50-degree field of view.
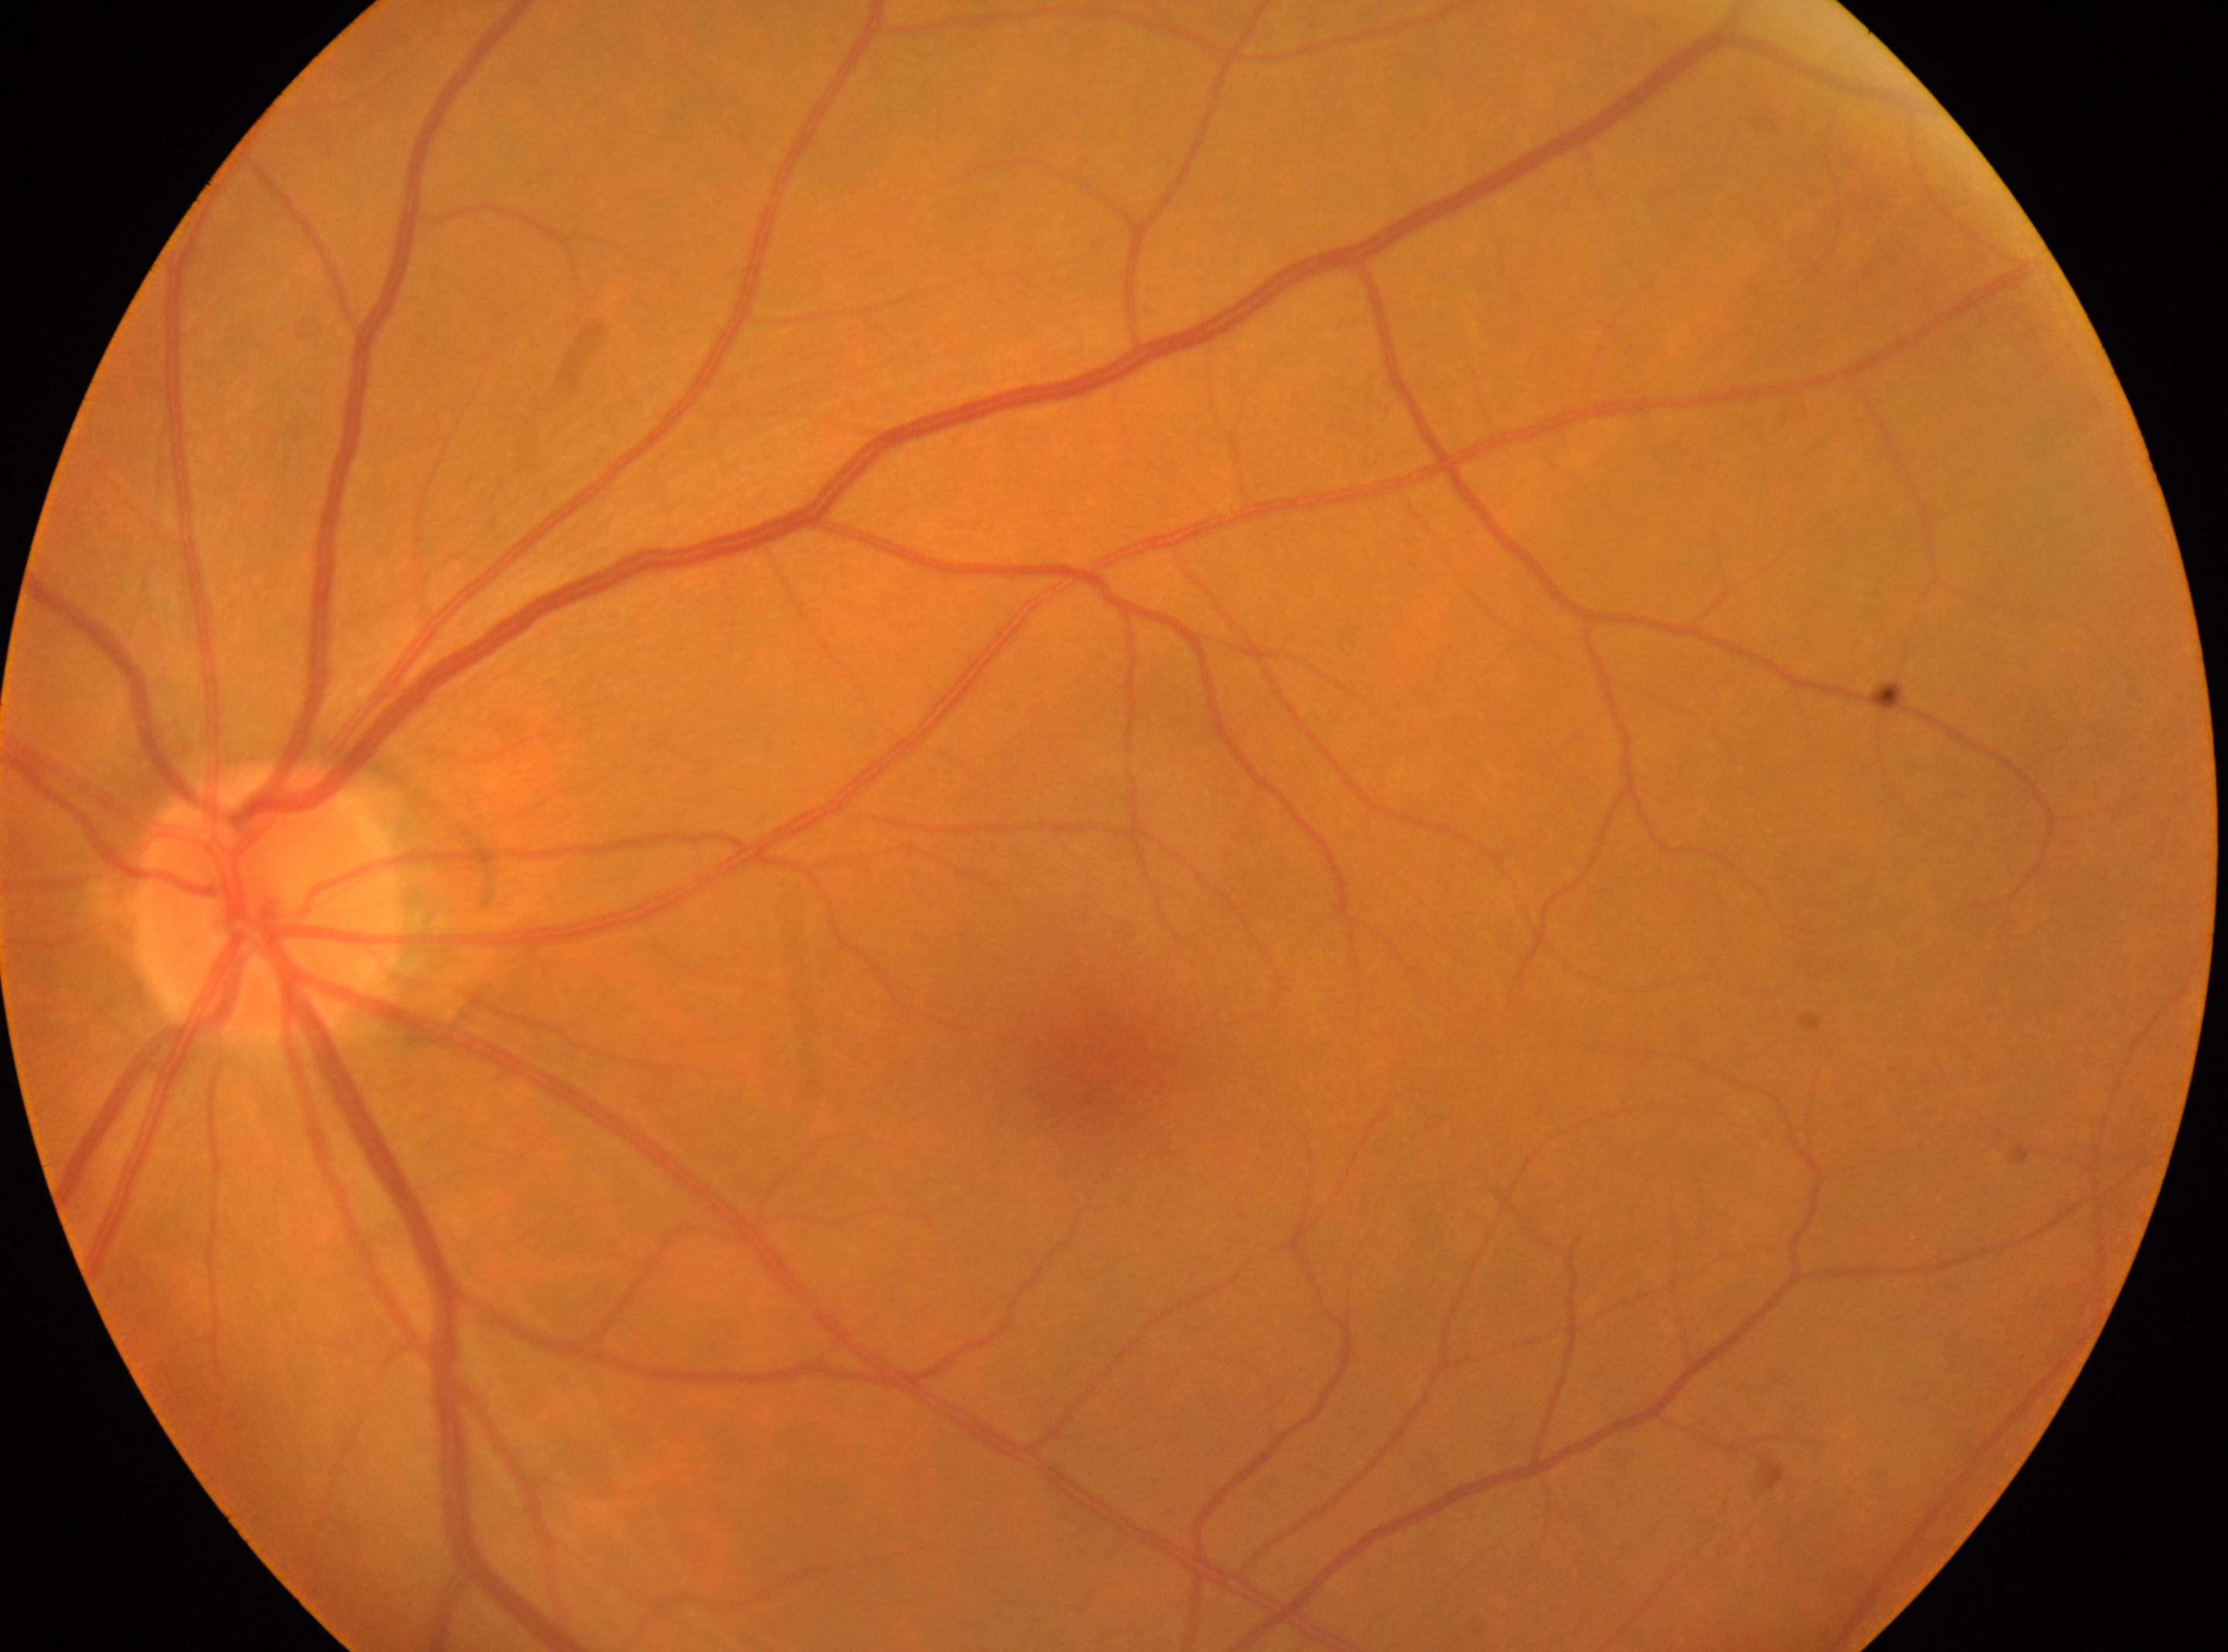 Annotations:
• macular center · 1088px, 1084px
• diabetic retinopathy · grade 0 (no apparent retinopathy)
• optic disk · 268px, 905px
• laterality · the left eye